50° field of view, Kowa VX-10α, 2361 by 1568 pixels, dilated-pupil acquisition: 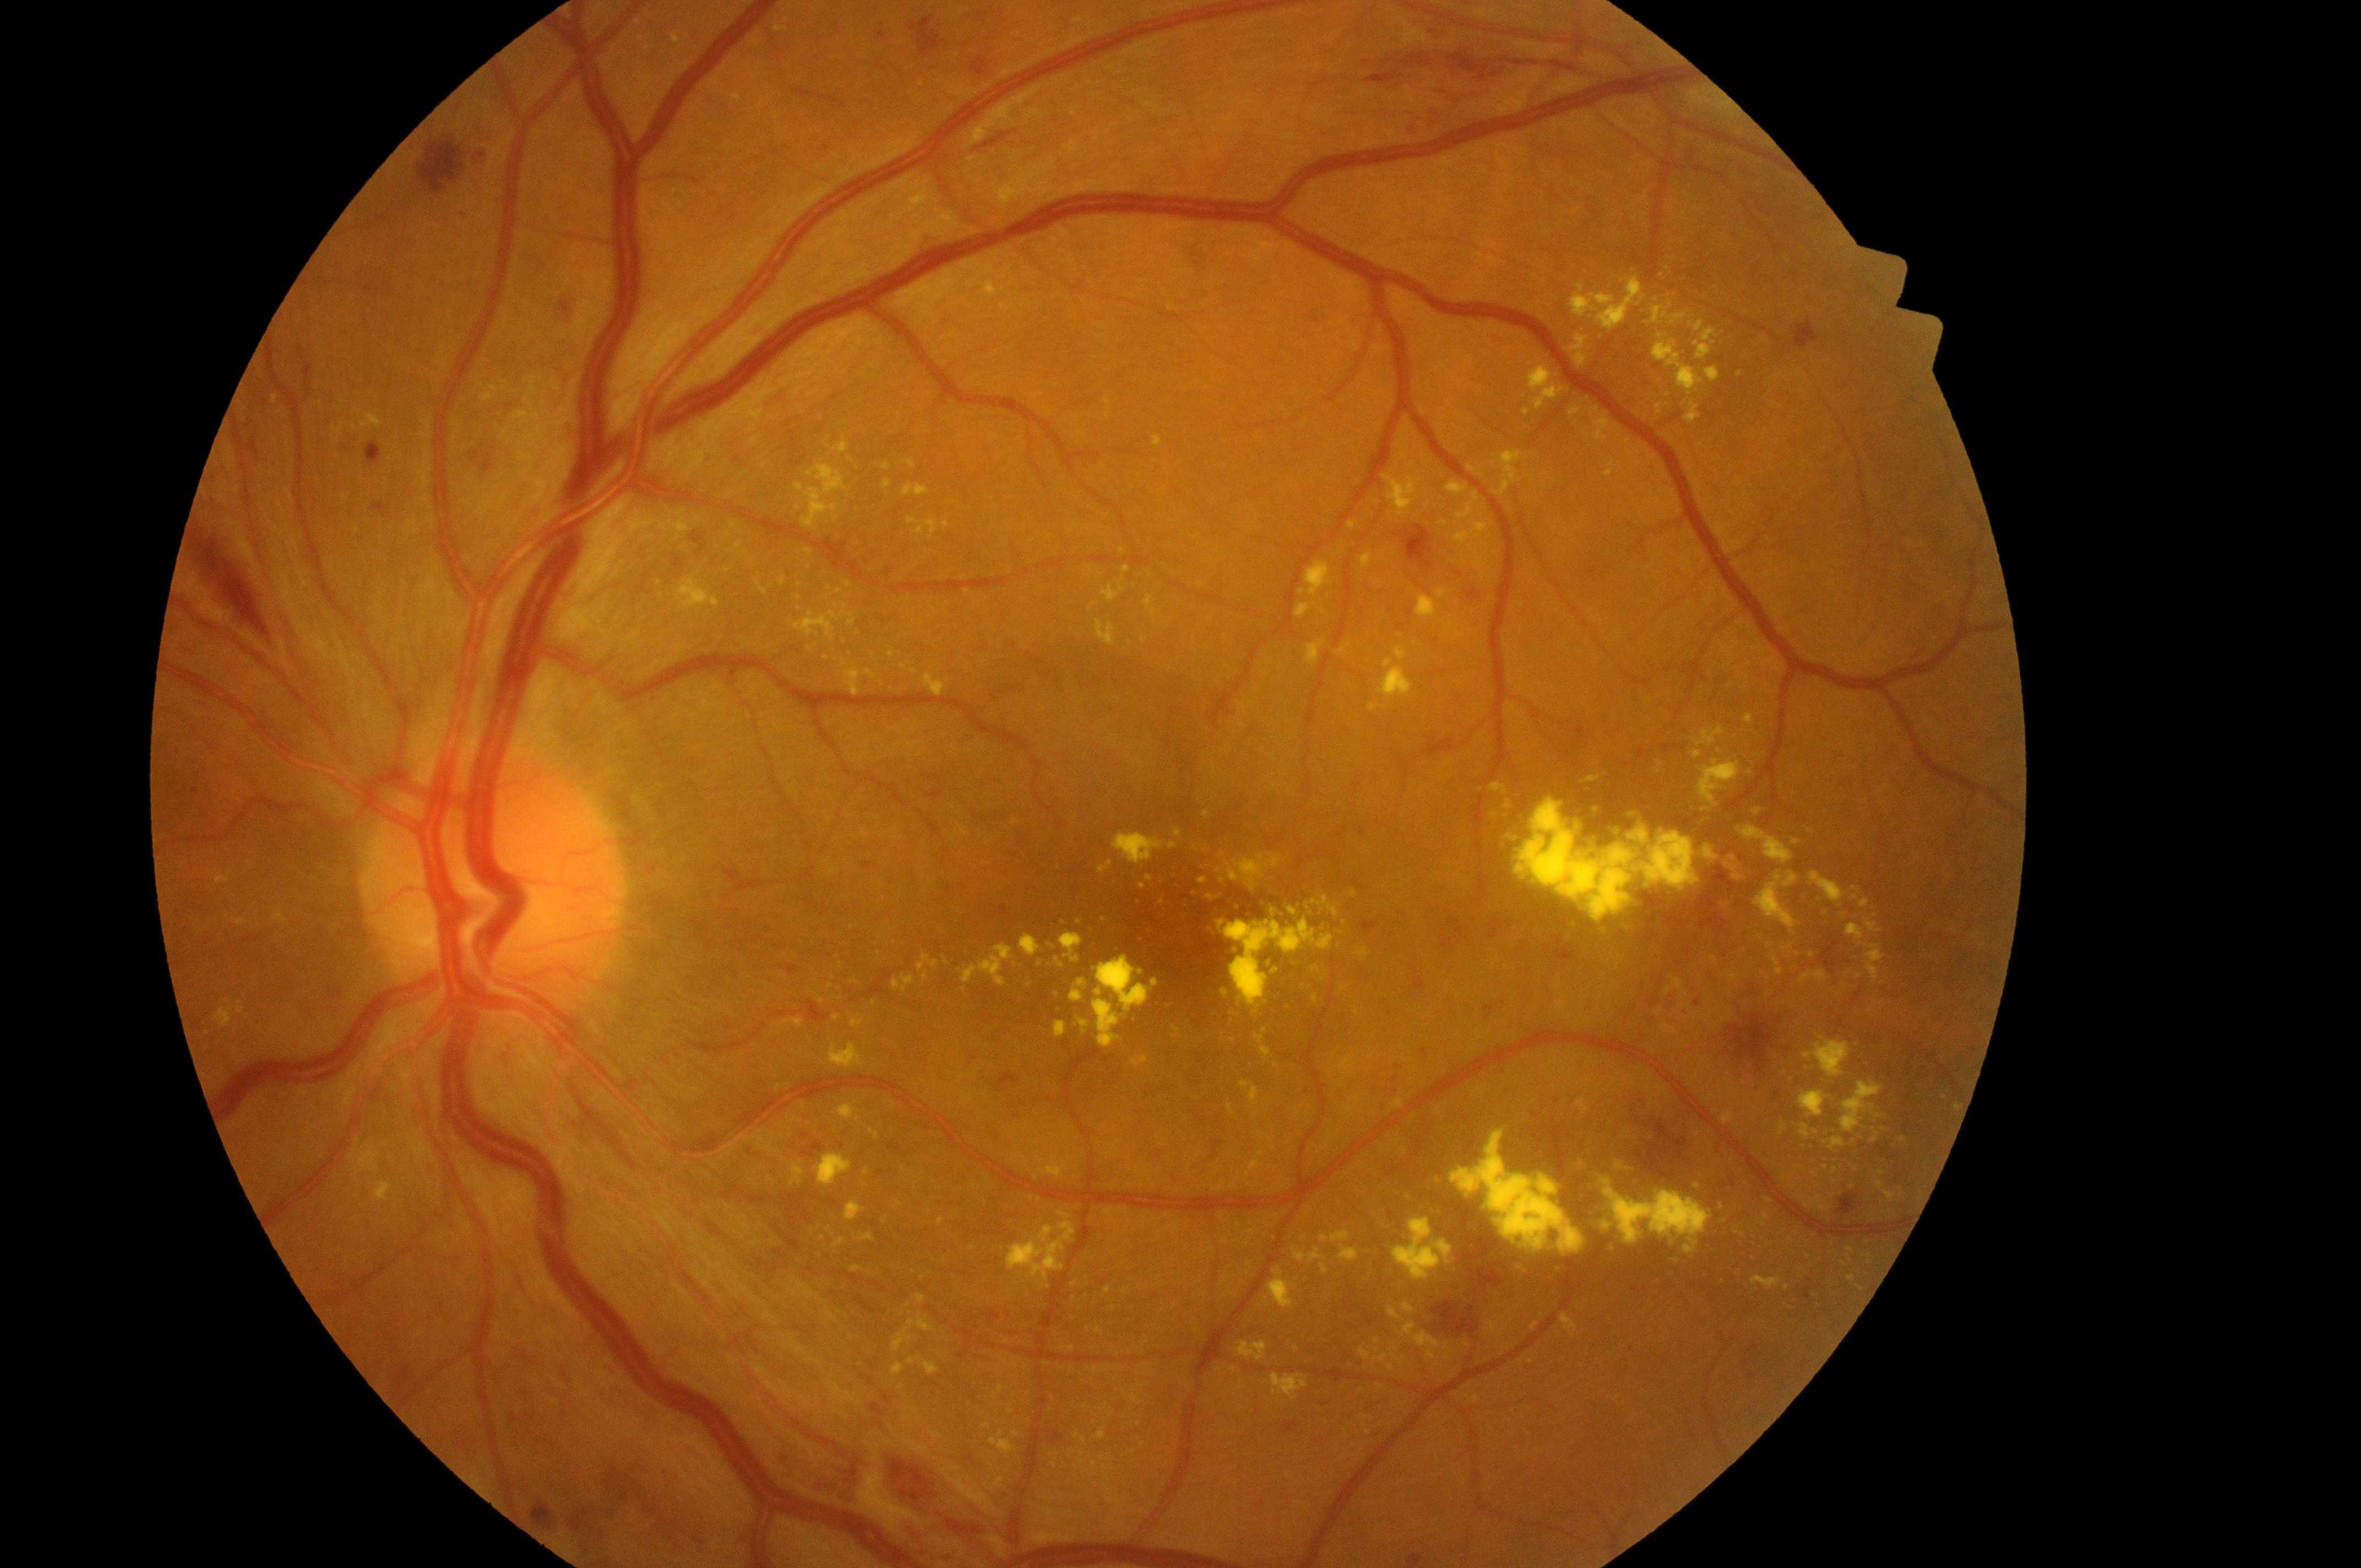
Optic nerve head: x=497, y=890. DME: grade 2 (high risk). This is the left eye. DR grade is severe non-proliferative diabetic retinopathy (3). Fovea: x=1176, y=930.